2212 by 1659 pixels, 45° FOV, retinal fundus photograph — 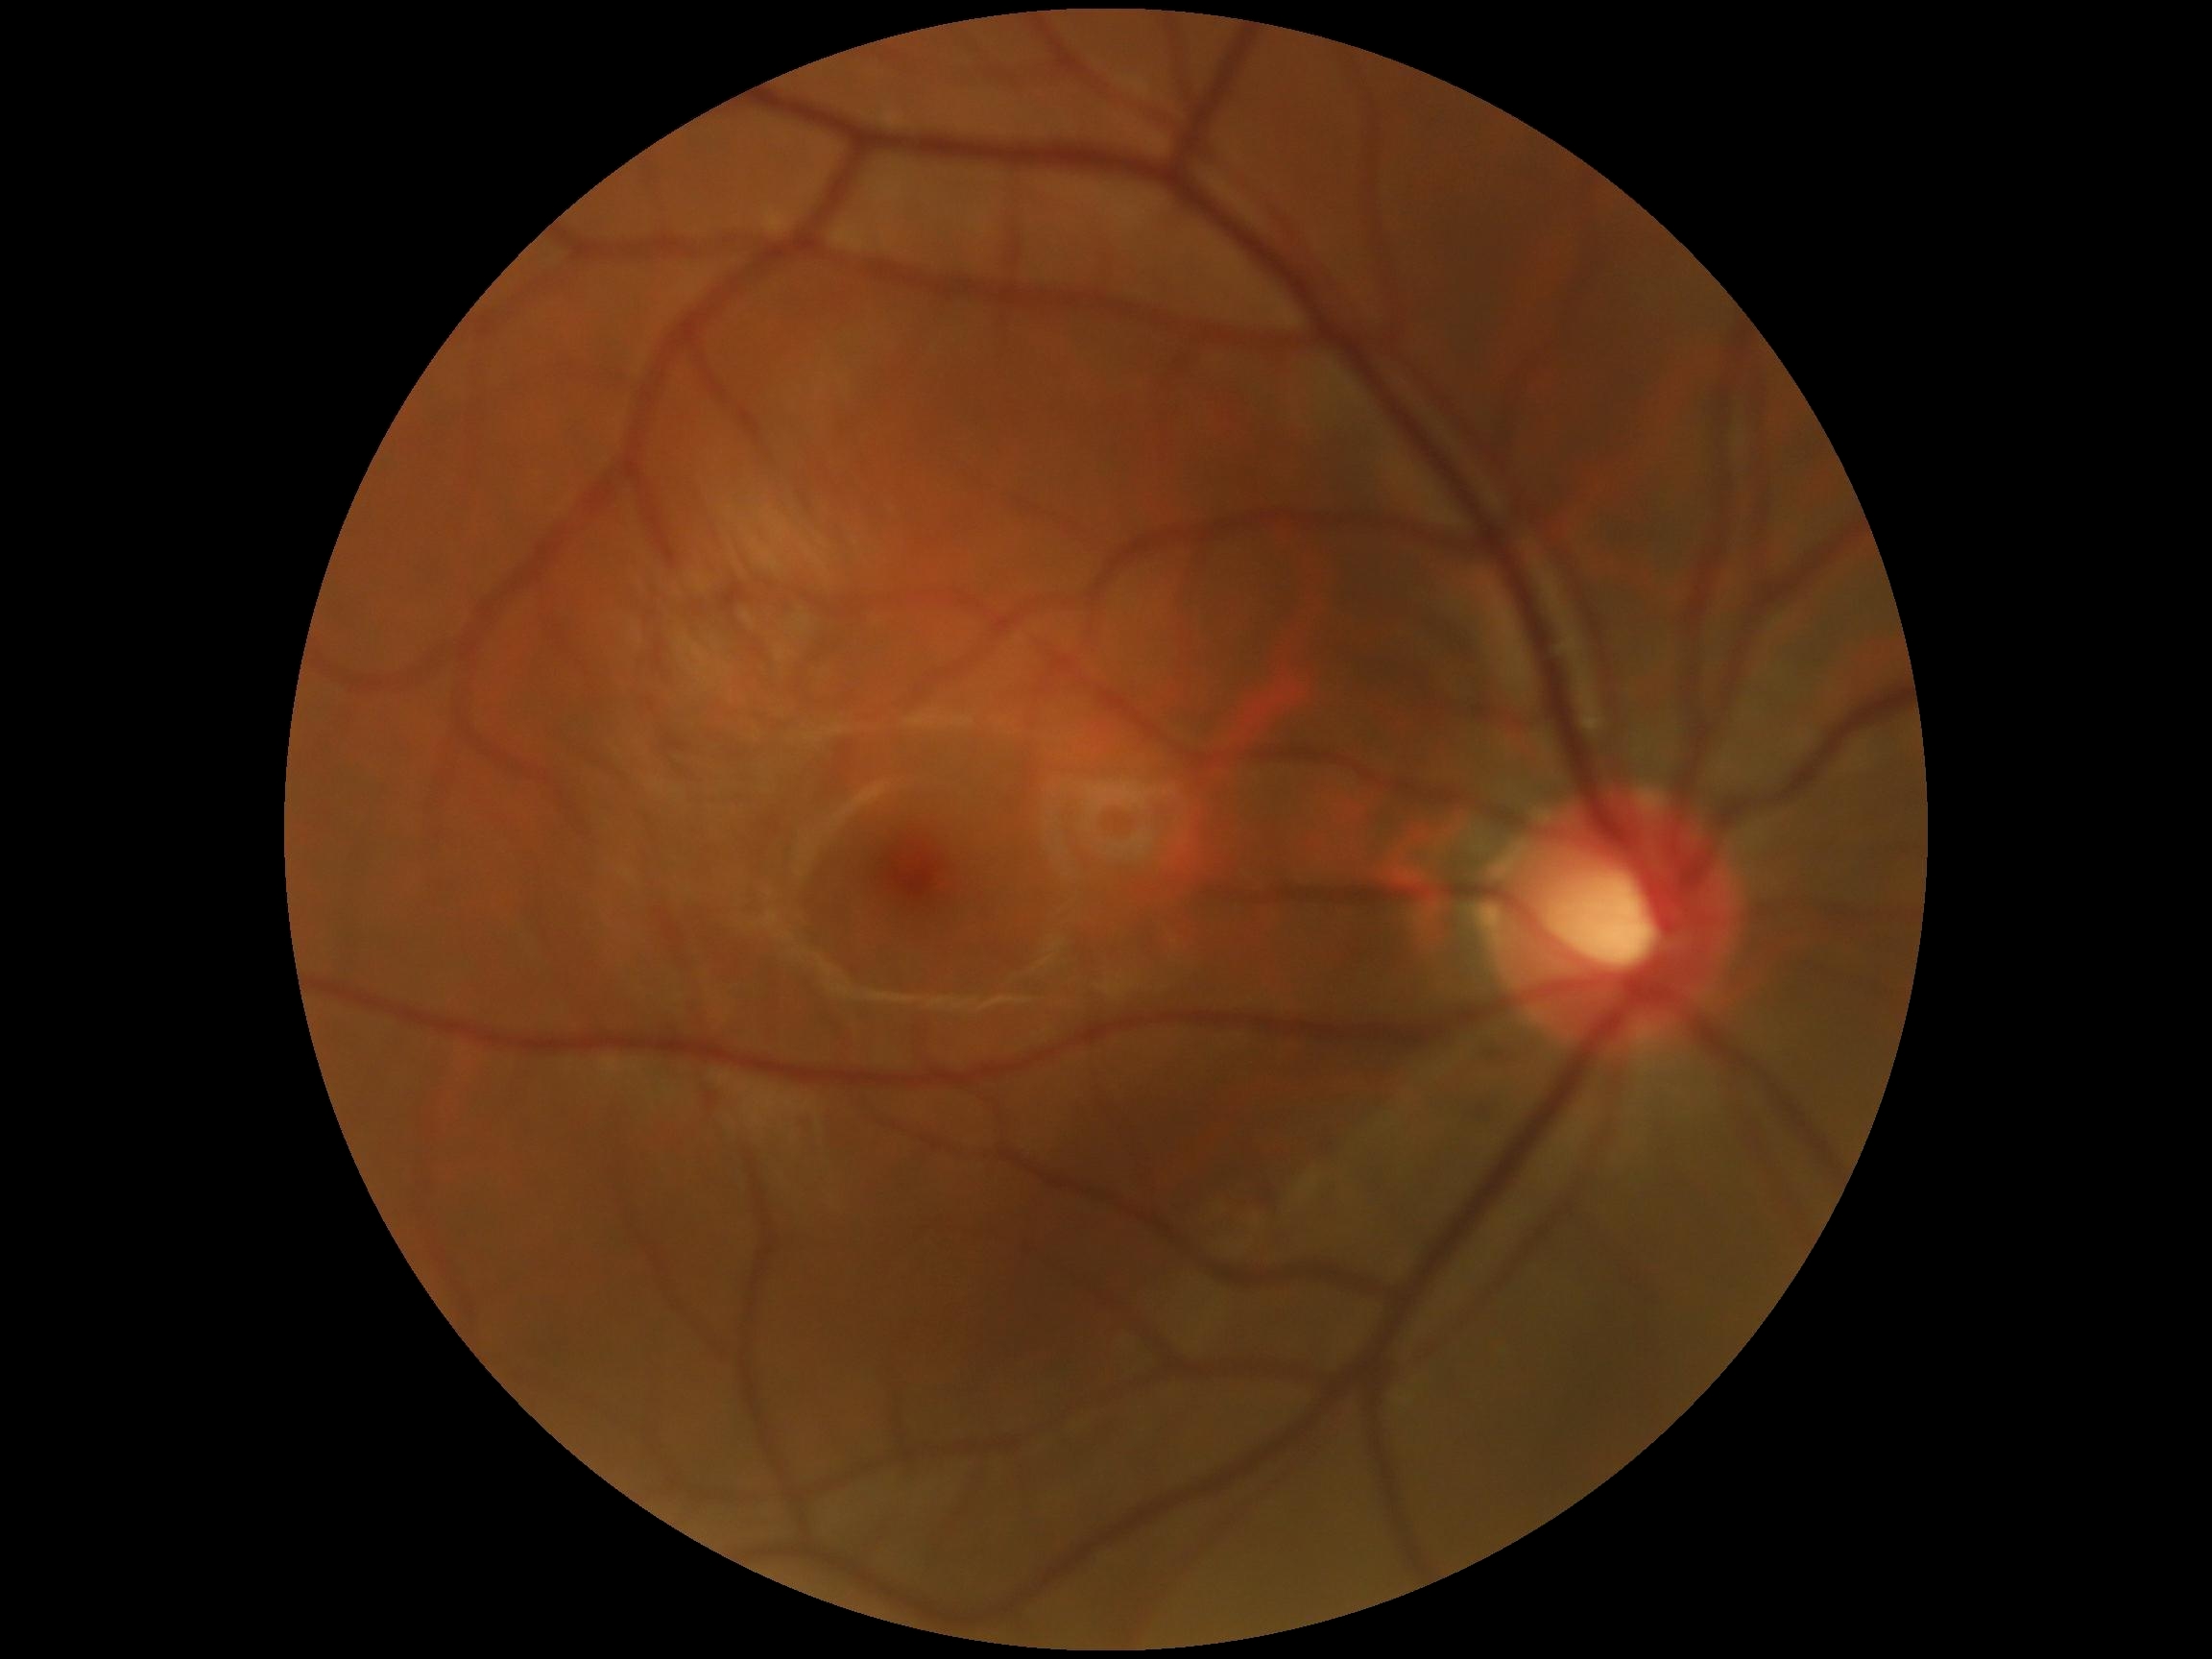

DR stage is grade 0 (no apparent retinopathy). No signs of diabetic retinopathy.